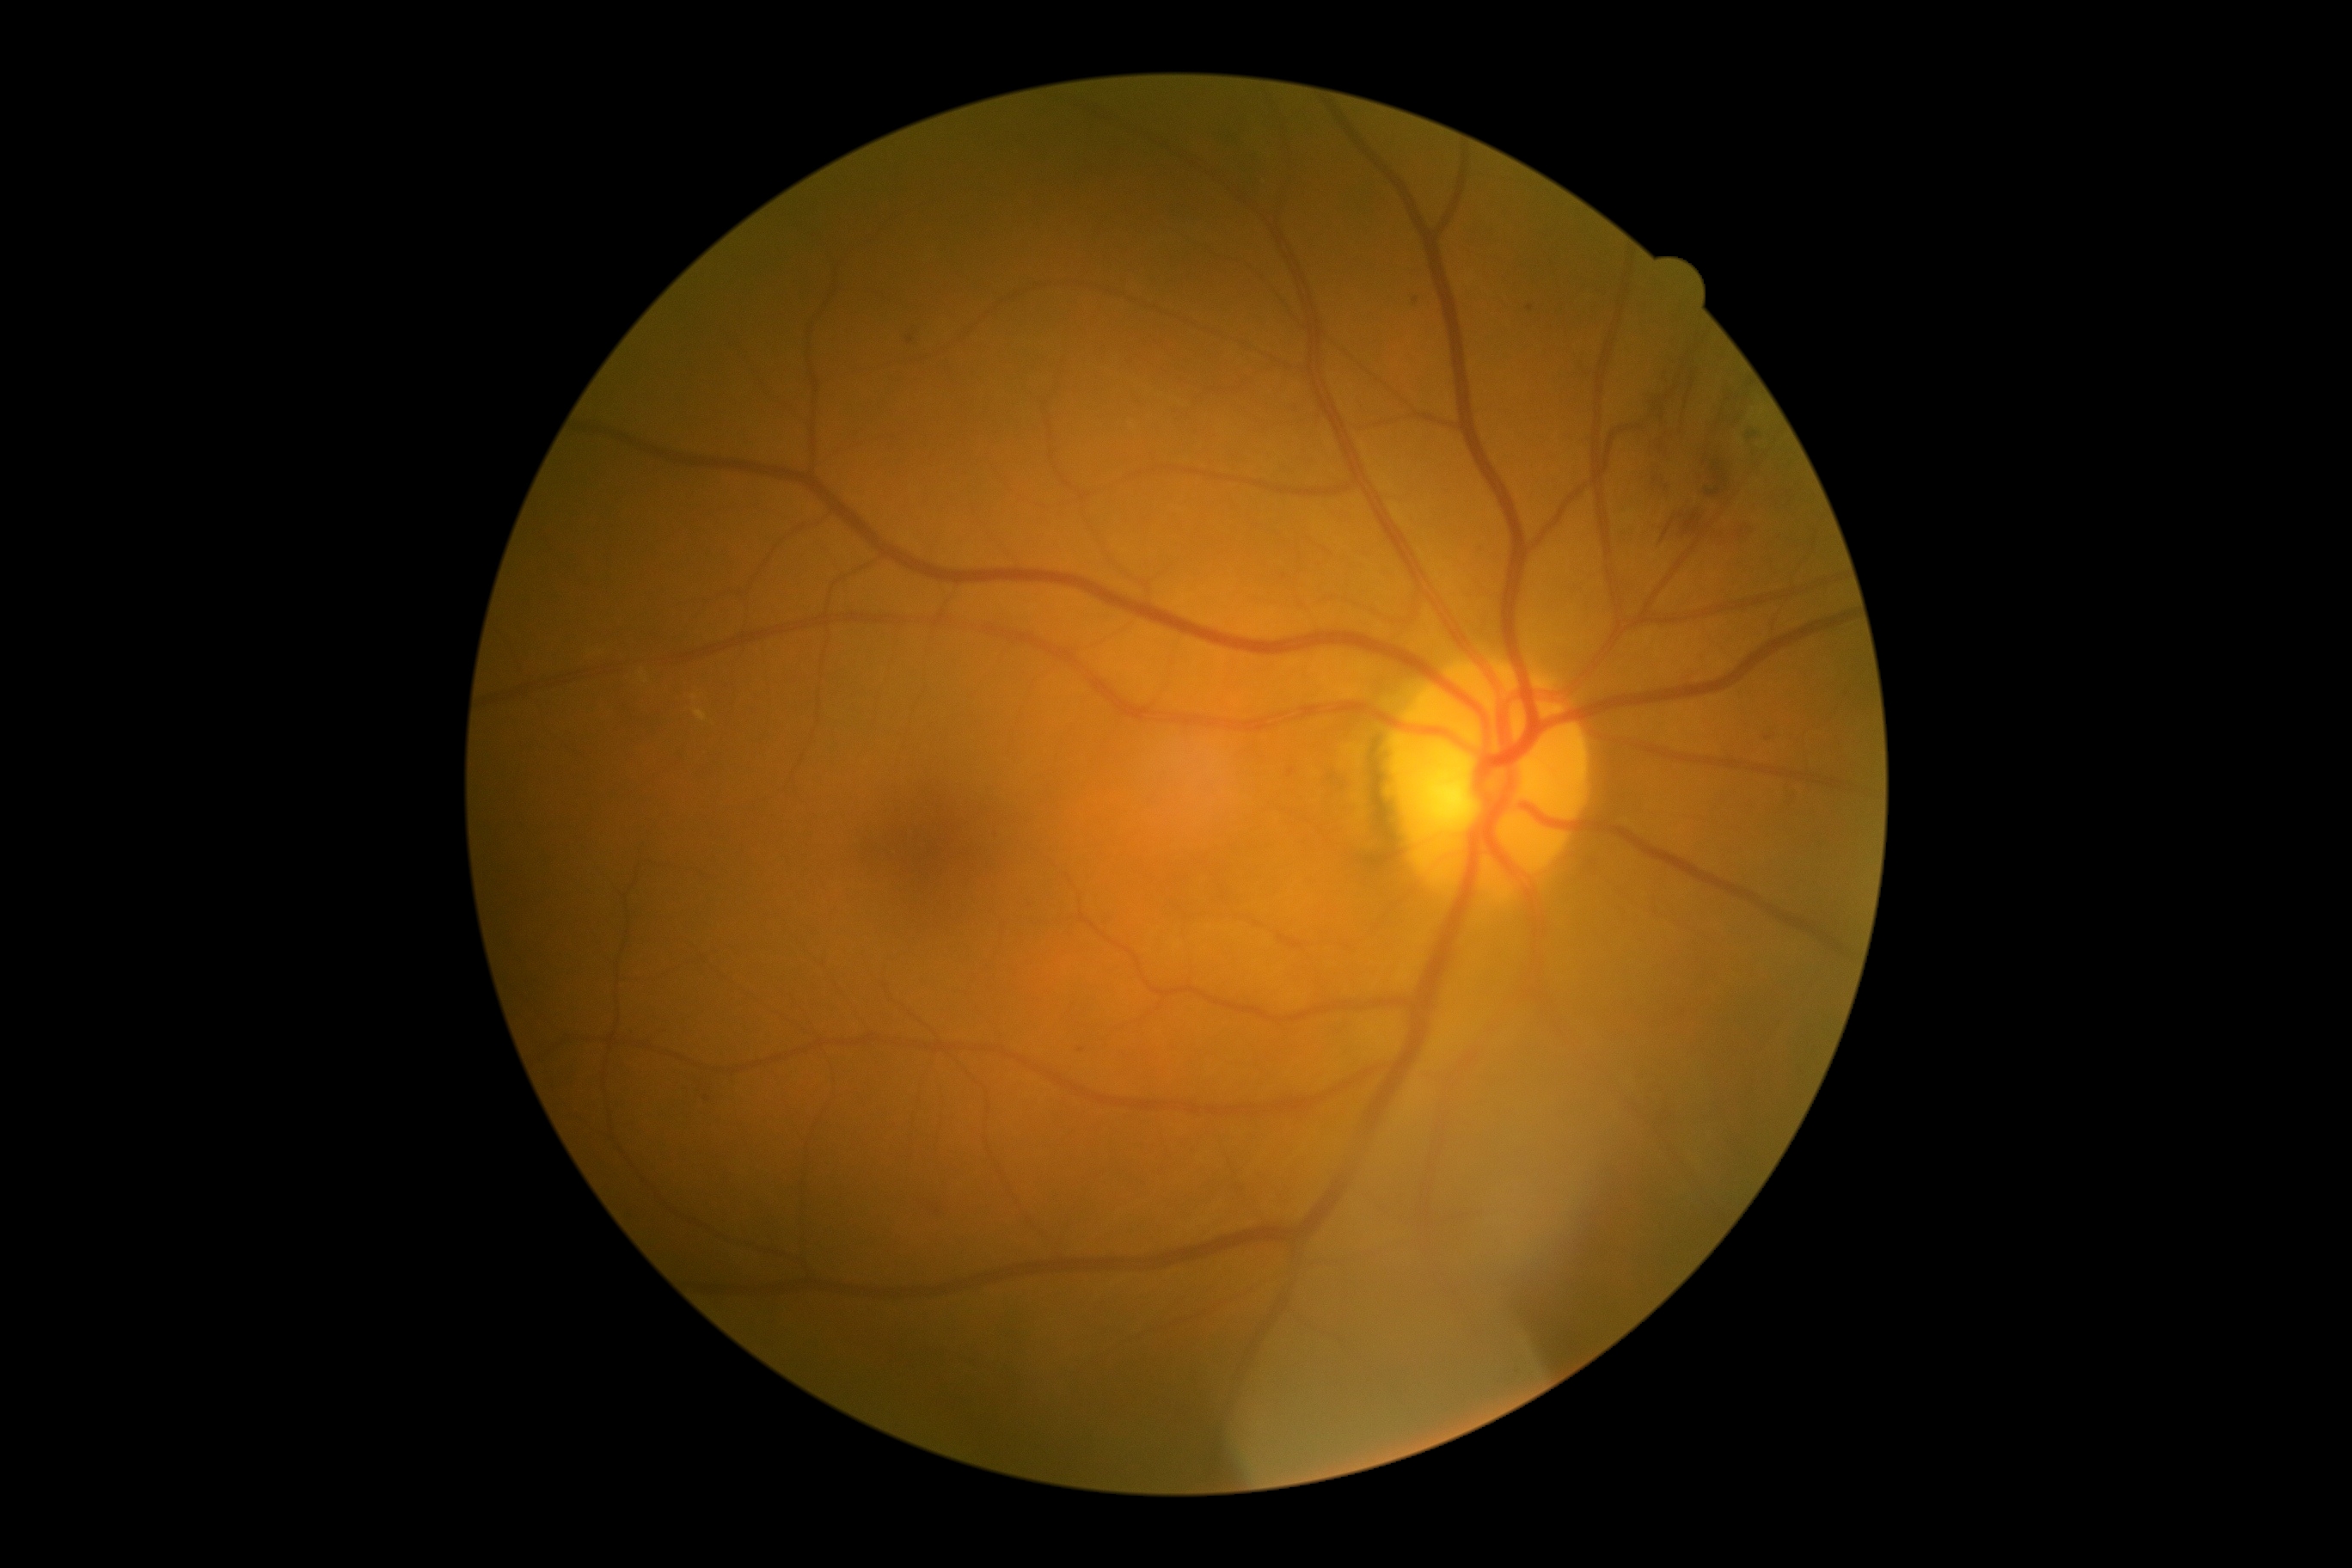
DR is grade 2 (moderate NPDR) — more than just microaneurysms but less than severe NPDR; non-proliferative diabetic retinopathy. HEs found at [1708,517,1751,548], [1227,135,1258,204], [1639,319,1773,548]. EXs found at [695,709,707,721]. Small EXs near x=647, y=680, x=695, y=697. MAs found at [1289,768,1295,776]. Small MAs near x=910, y=341, x=1531, y=308, x=1082, y=1050, x=1283, y=577, x=1416, y=300, x=707, y=1097, x=938, y=1211, x=1767, y=738. No SEs identified.